848x848px. Color fundus image:
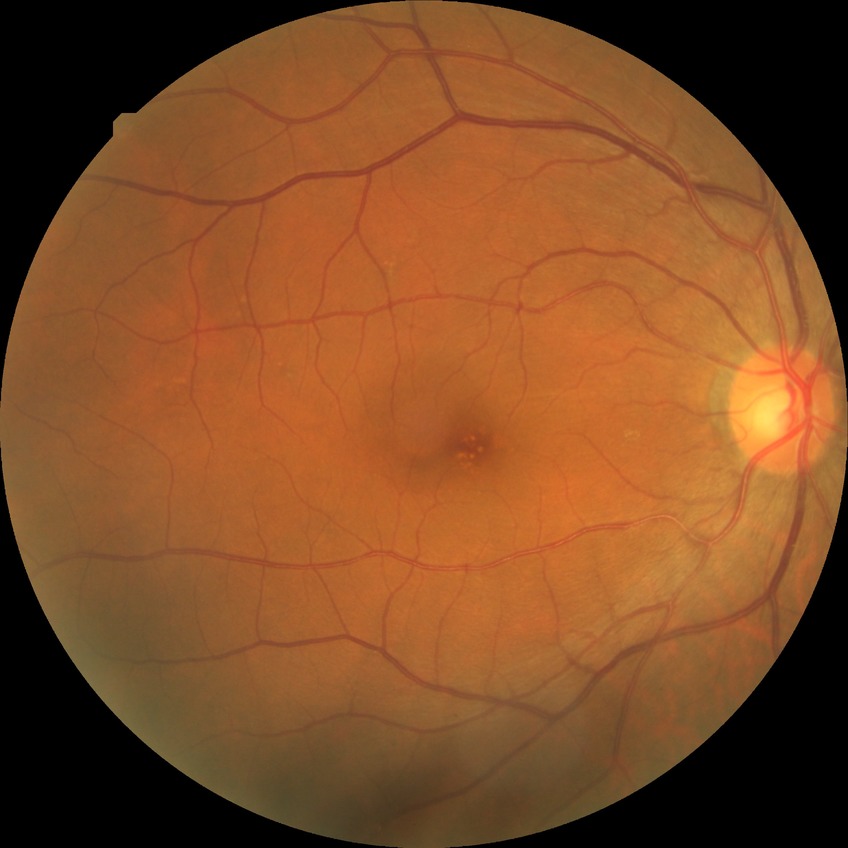 Diabetic retinopathy severity: no diabetic retinopathy.